45° FOV:
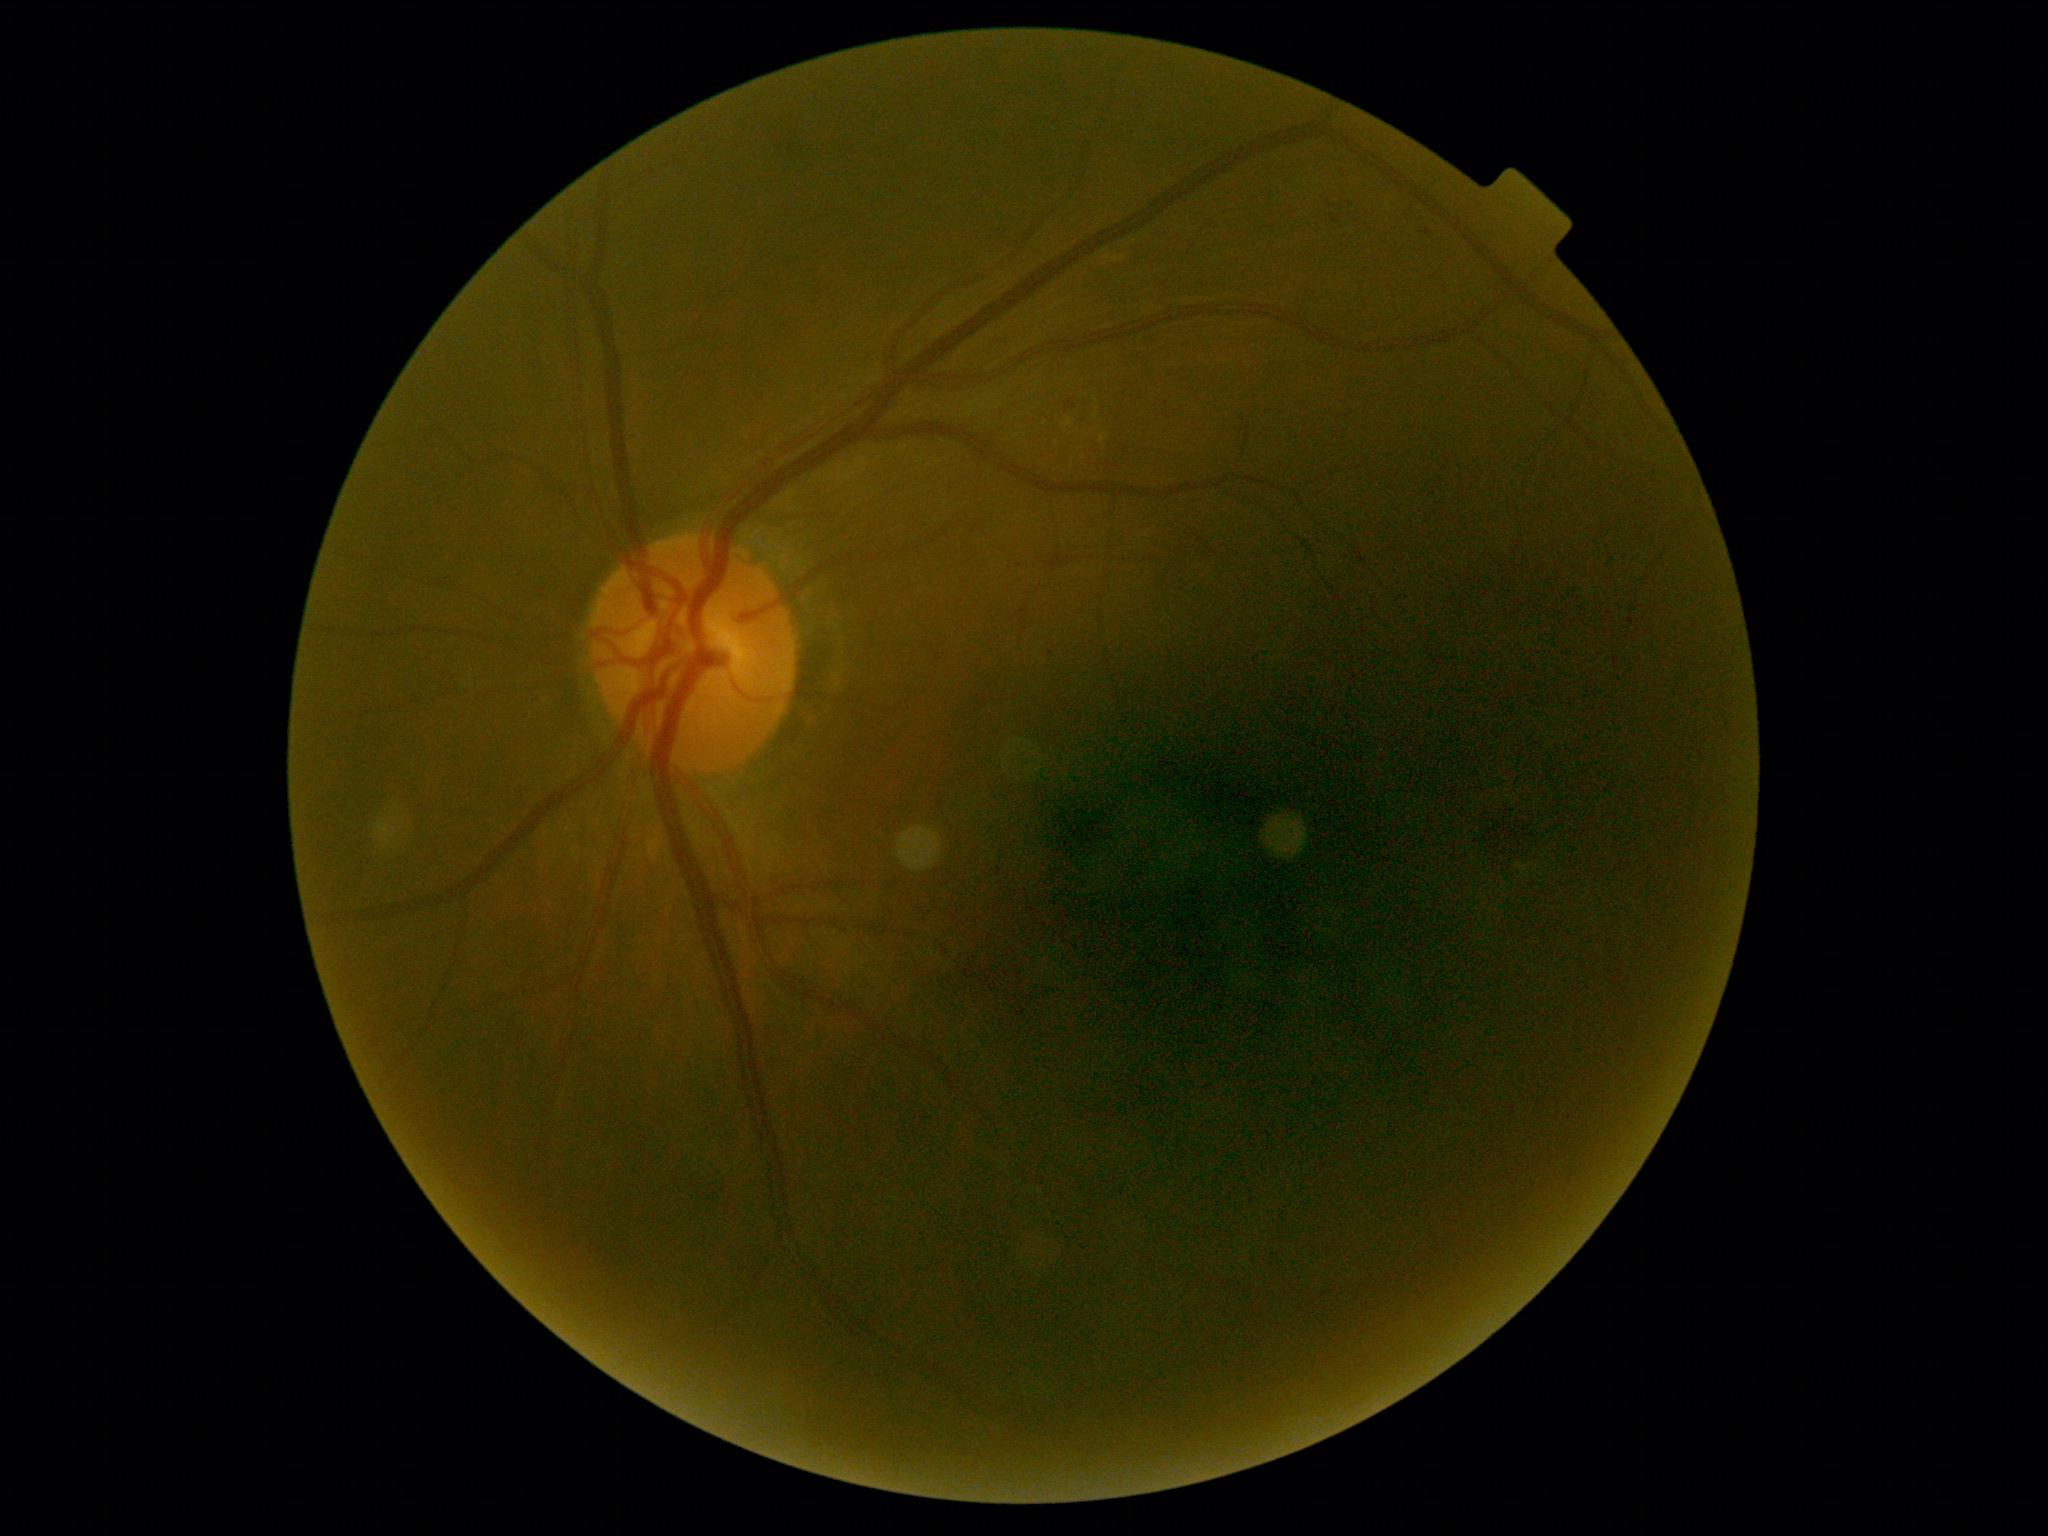
Findings:
- diabetic retinopathy (DR) — grade 2